CFP · acquired with a Nidek AFC-330:
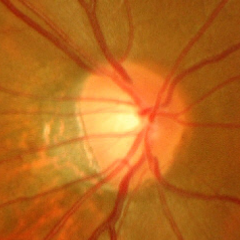
The image shows advanced glaucomatous optic neuropathy.